FOV: 50 degrees, fundus photo
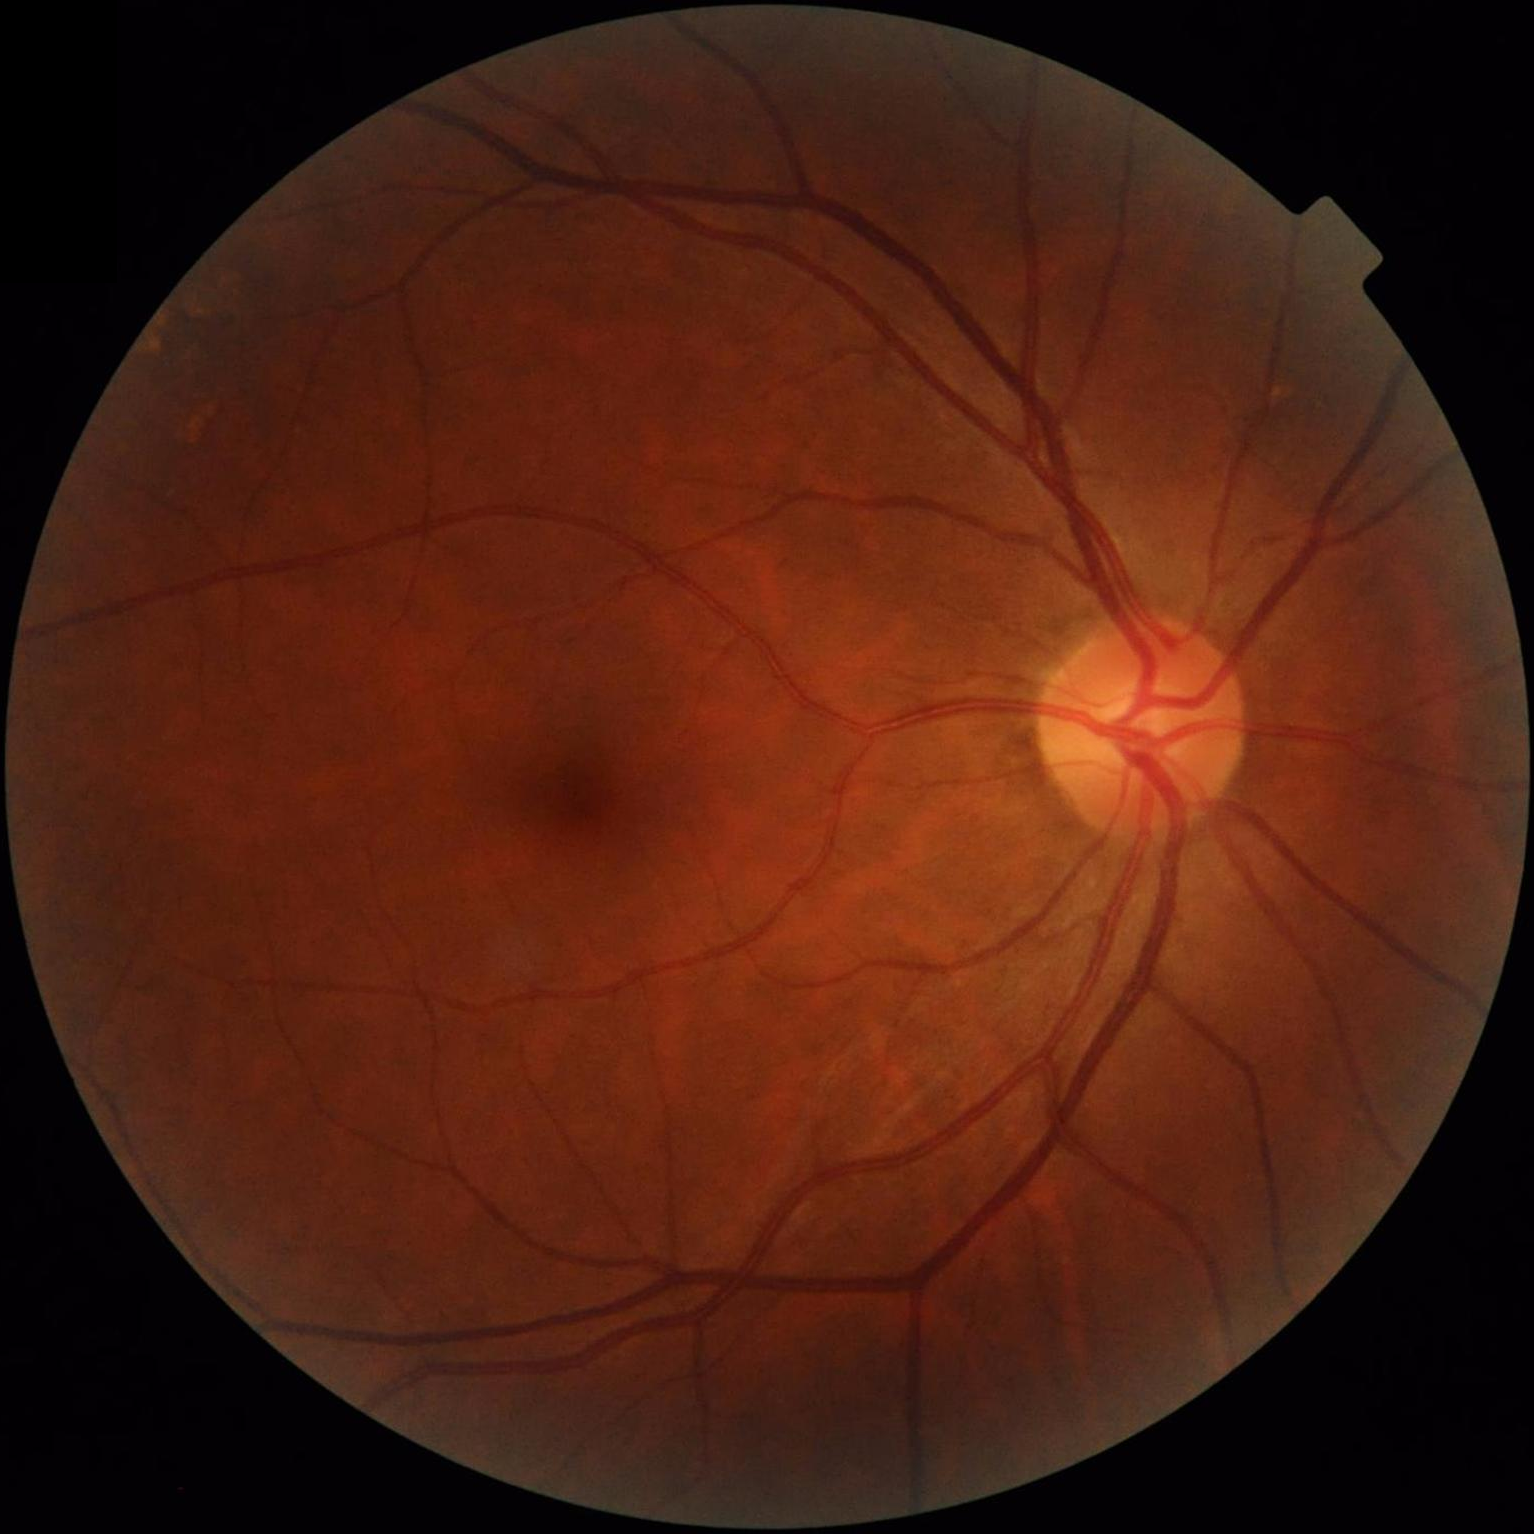

Image quality is adequate for diagnostic use. Optic disc, vessels, and background are in focus. Illumination and color balance are good.